Pediatric wide-field fundus photograph
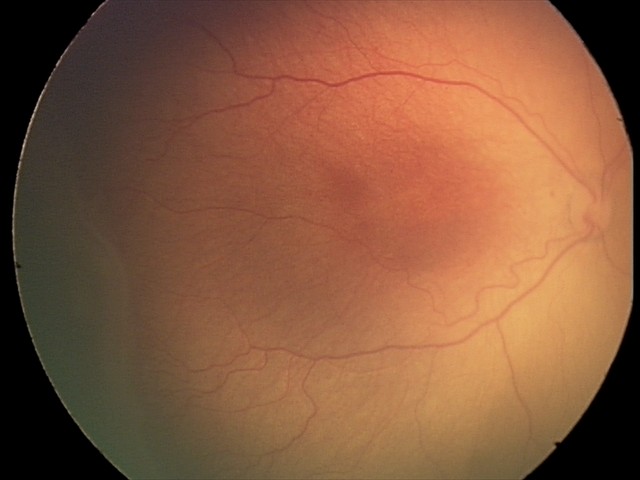 Without plus disease.
From an examination with diagnosis of ROP stage 2.